Pediatric wide-field fundus photograph: 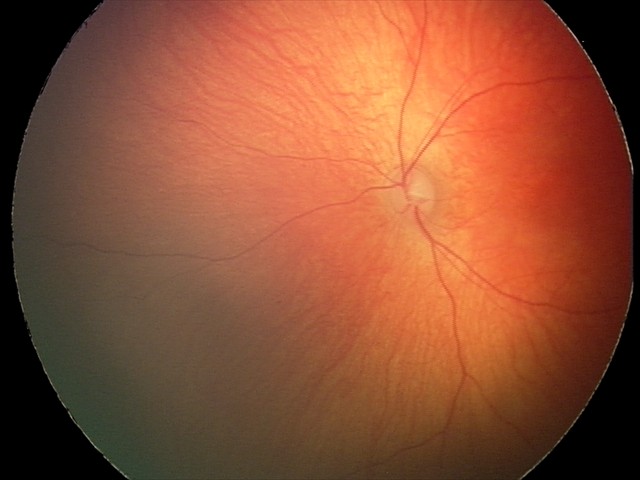 Assessment: physiological finding.